Without pupil dilation · NIDEK AFC-230 fundus camera
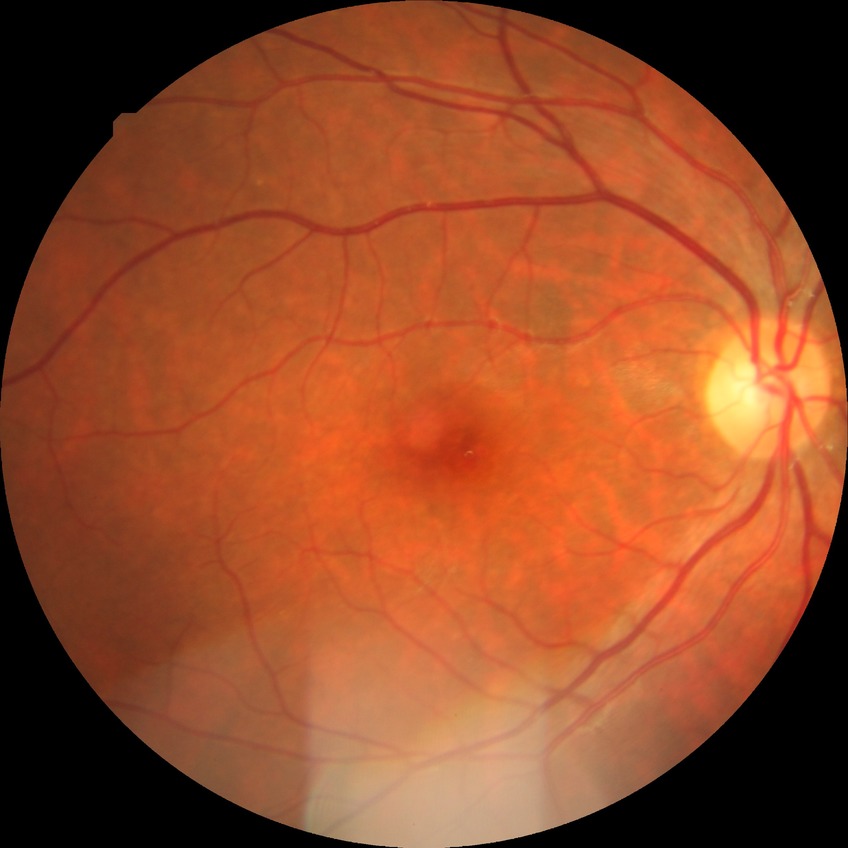

Diabetic retinopathy (DR) is no diabetic retinopathy (NDR).